45-degree field of view, 2352 by 1568 pixels — 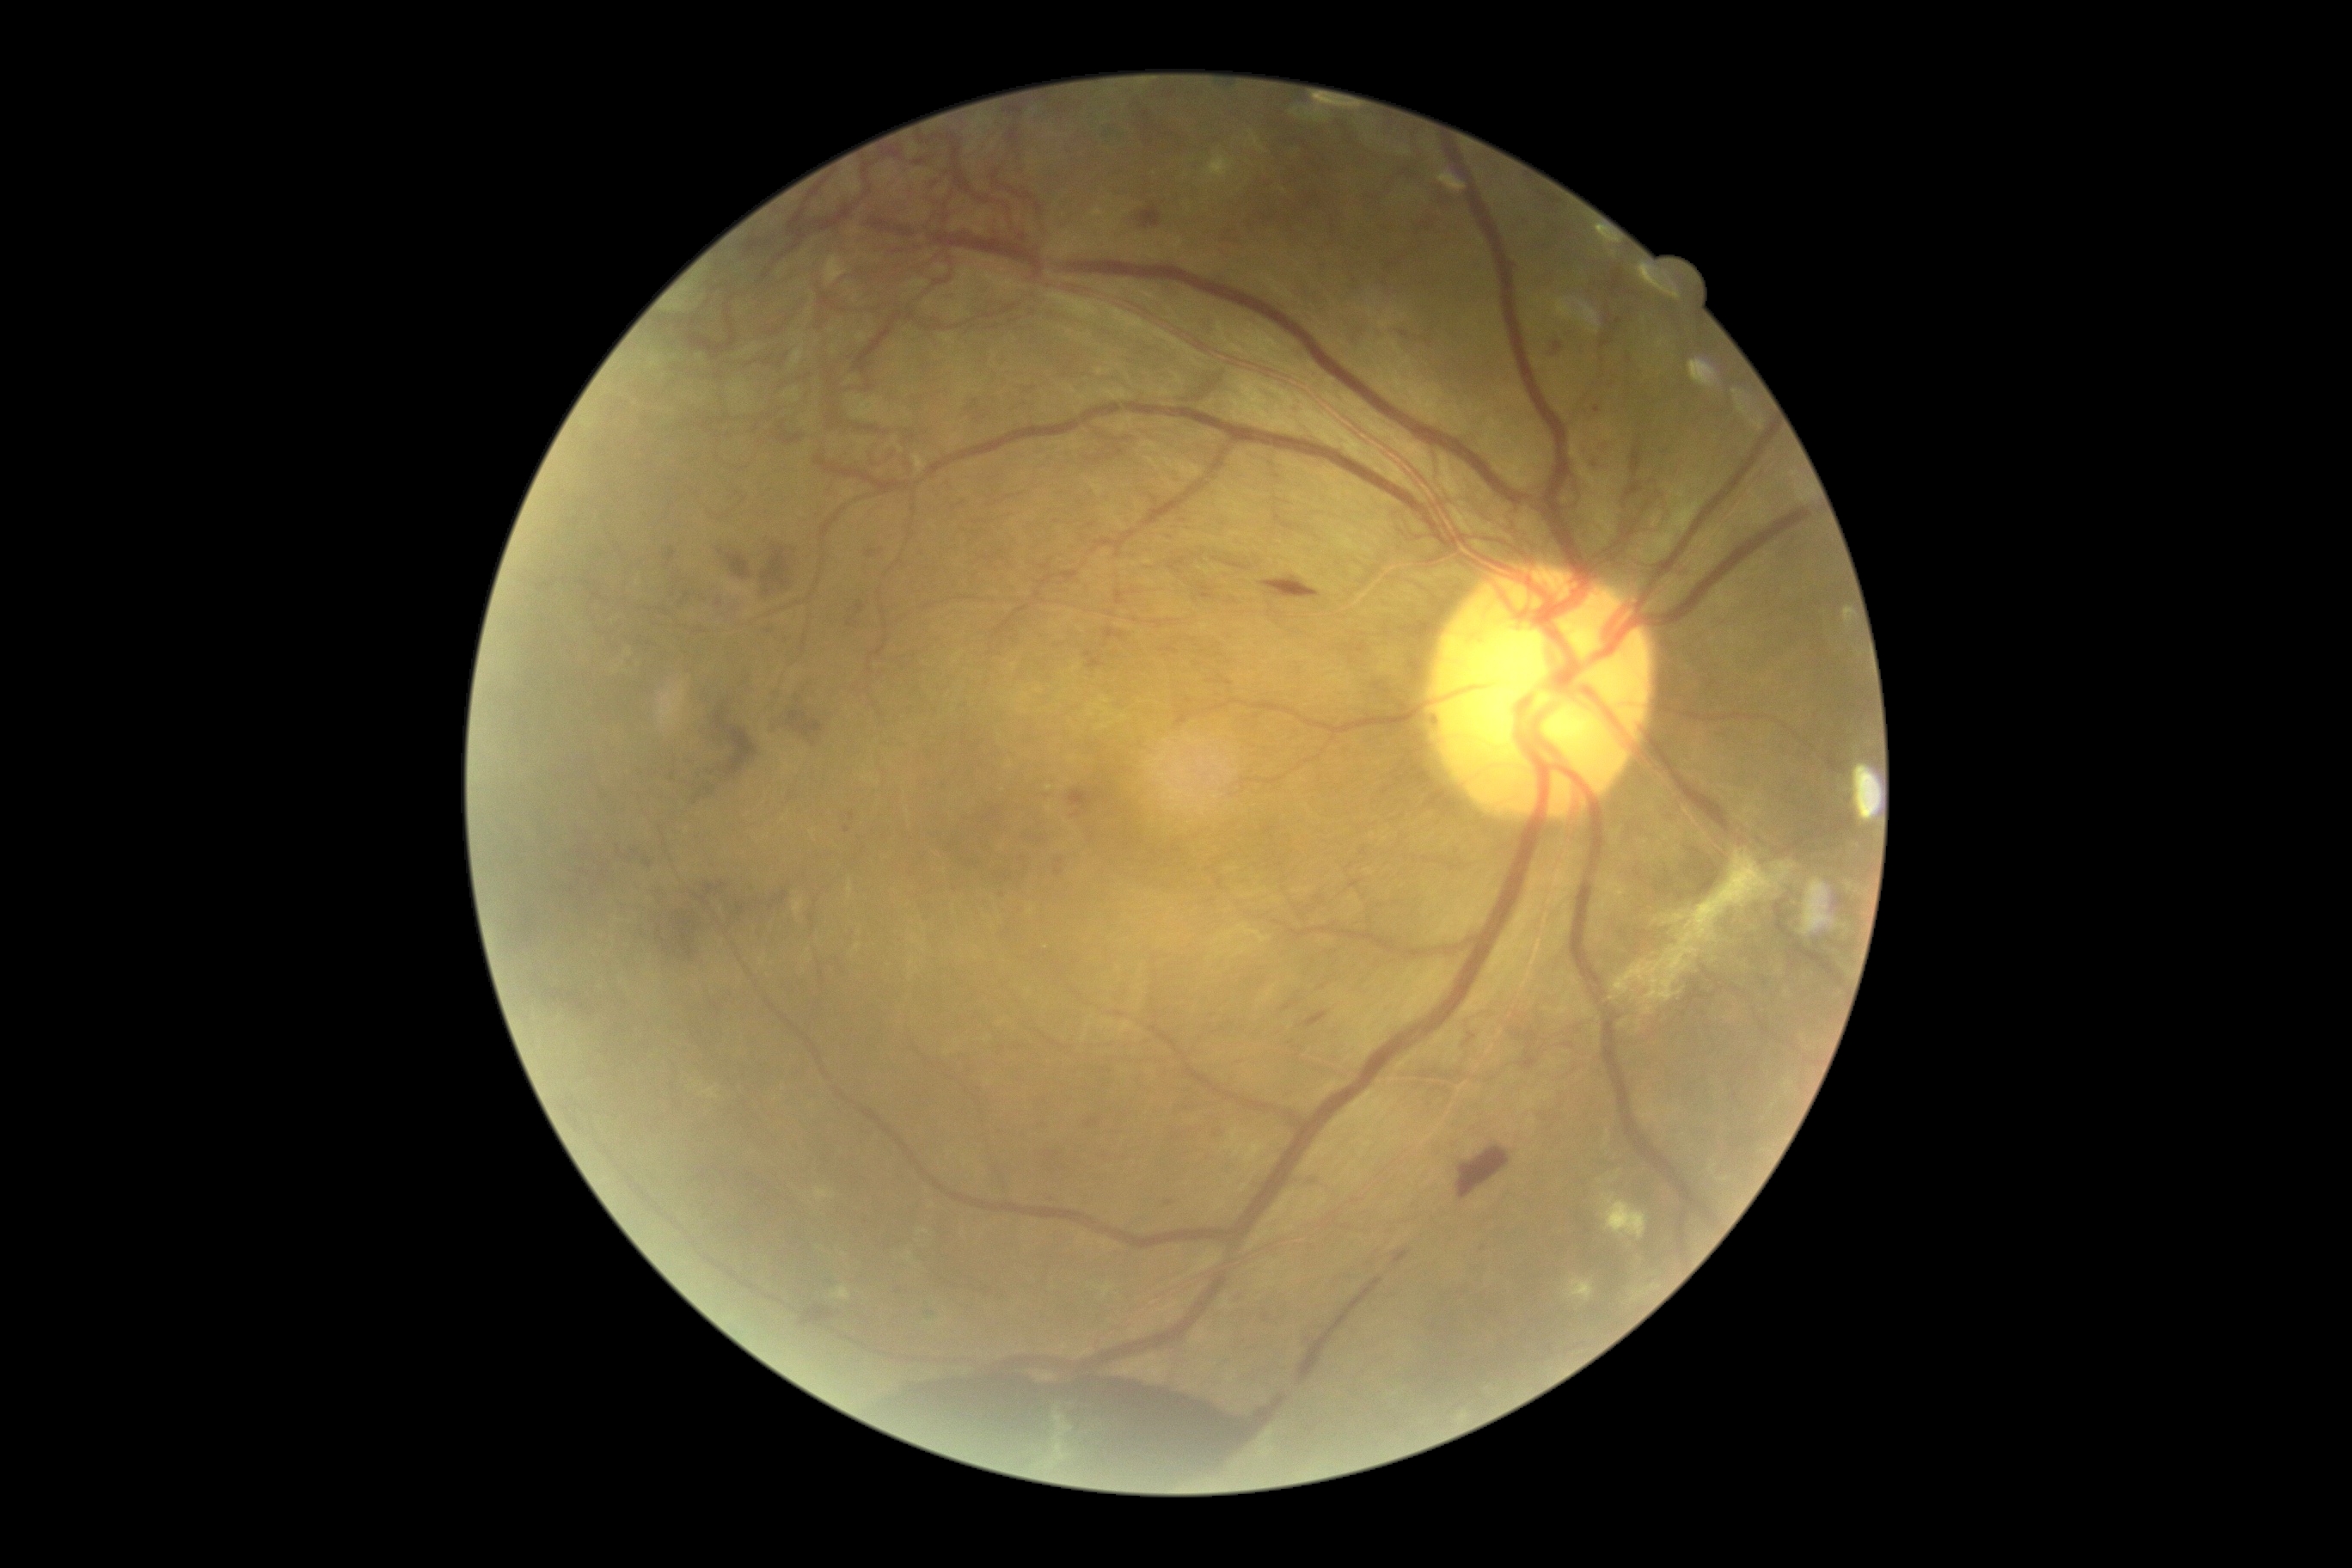 Diabetic retinopathy (DR): grade 4 (PDR)
Representative lesions:
hemorrhages (HEs) (more not shown): 644/859/652/869 | 763/623/778/637 | 541/983/592/1019 | 1124/204/1165/233 | 666/549/677/568 | 1595/407/1602/415 | 1057/859/1065/864 | 630/879/785/967 | 917/544/933/561 | 1548/340/1565/362 | 1087/658/1105/670 | 757/532/800/603 | 962/395/996/422 | 859/544/886/561 | 1014/383/1036/412
Additional small HEs near 1051/1156 | 634/852 | 1483/1249